1240x1240px. Phoenix ICON, 100° FOV. Wide-field contact fundus photograph of an infant
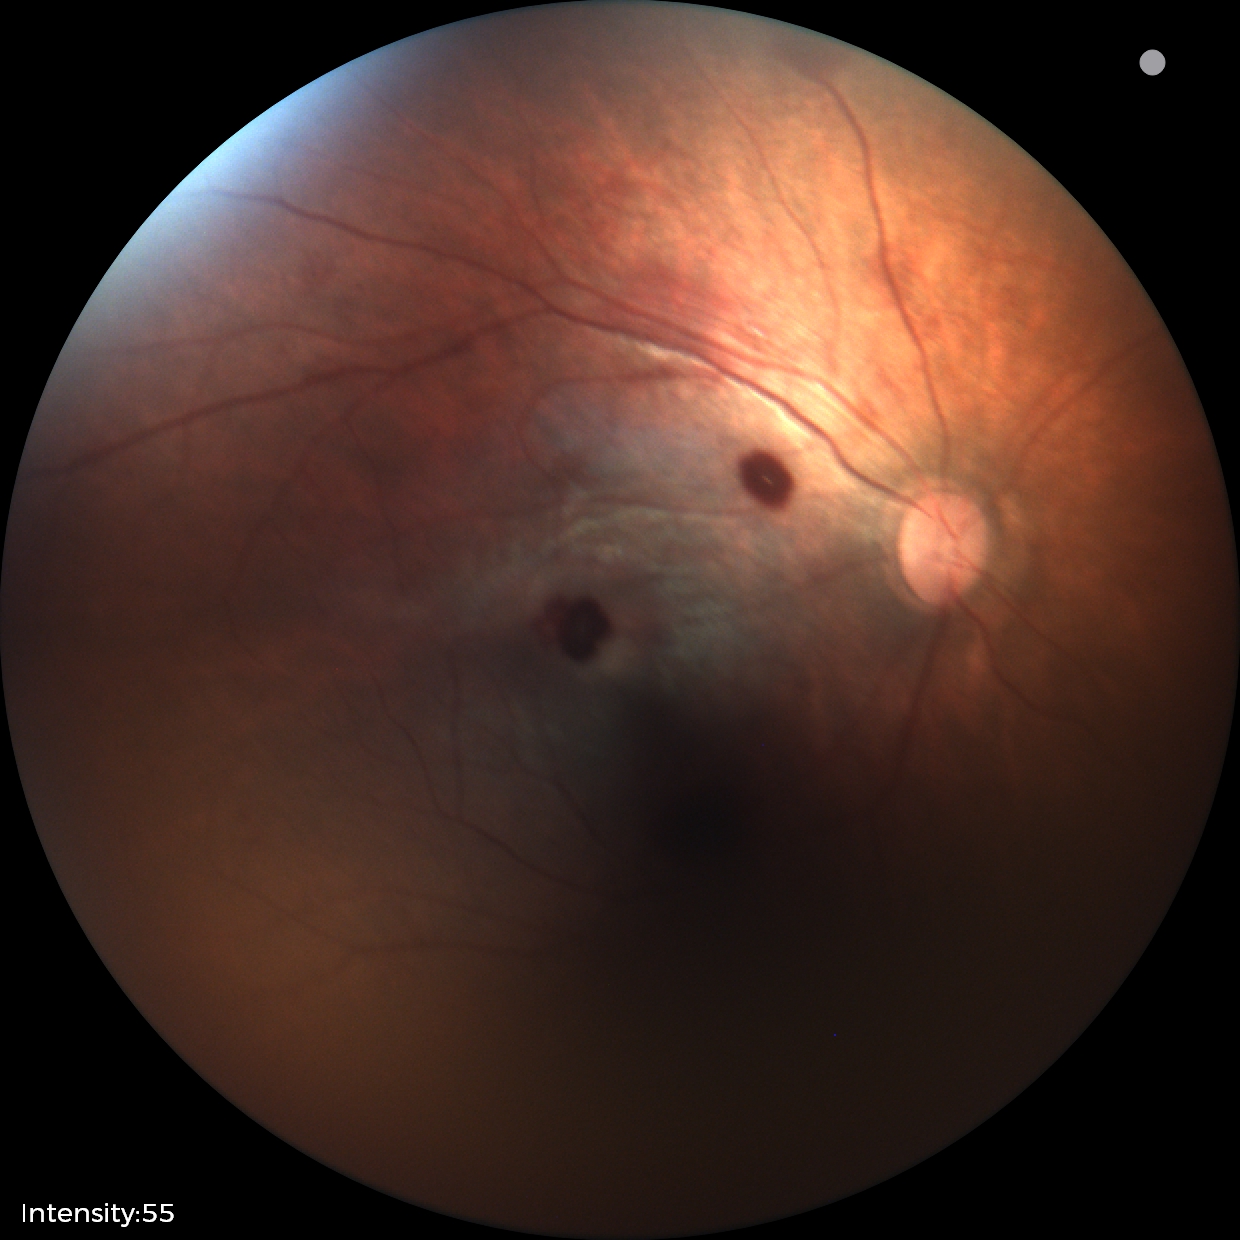

From an examination with diagnosis of retinal hemorrhages.